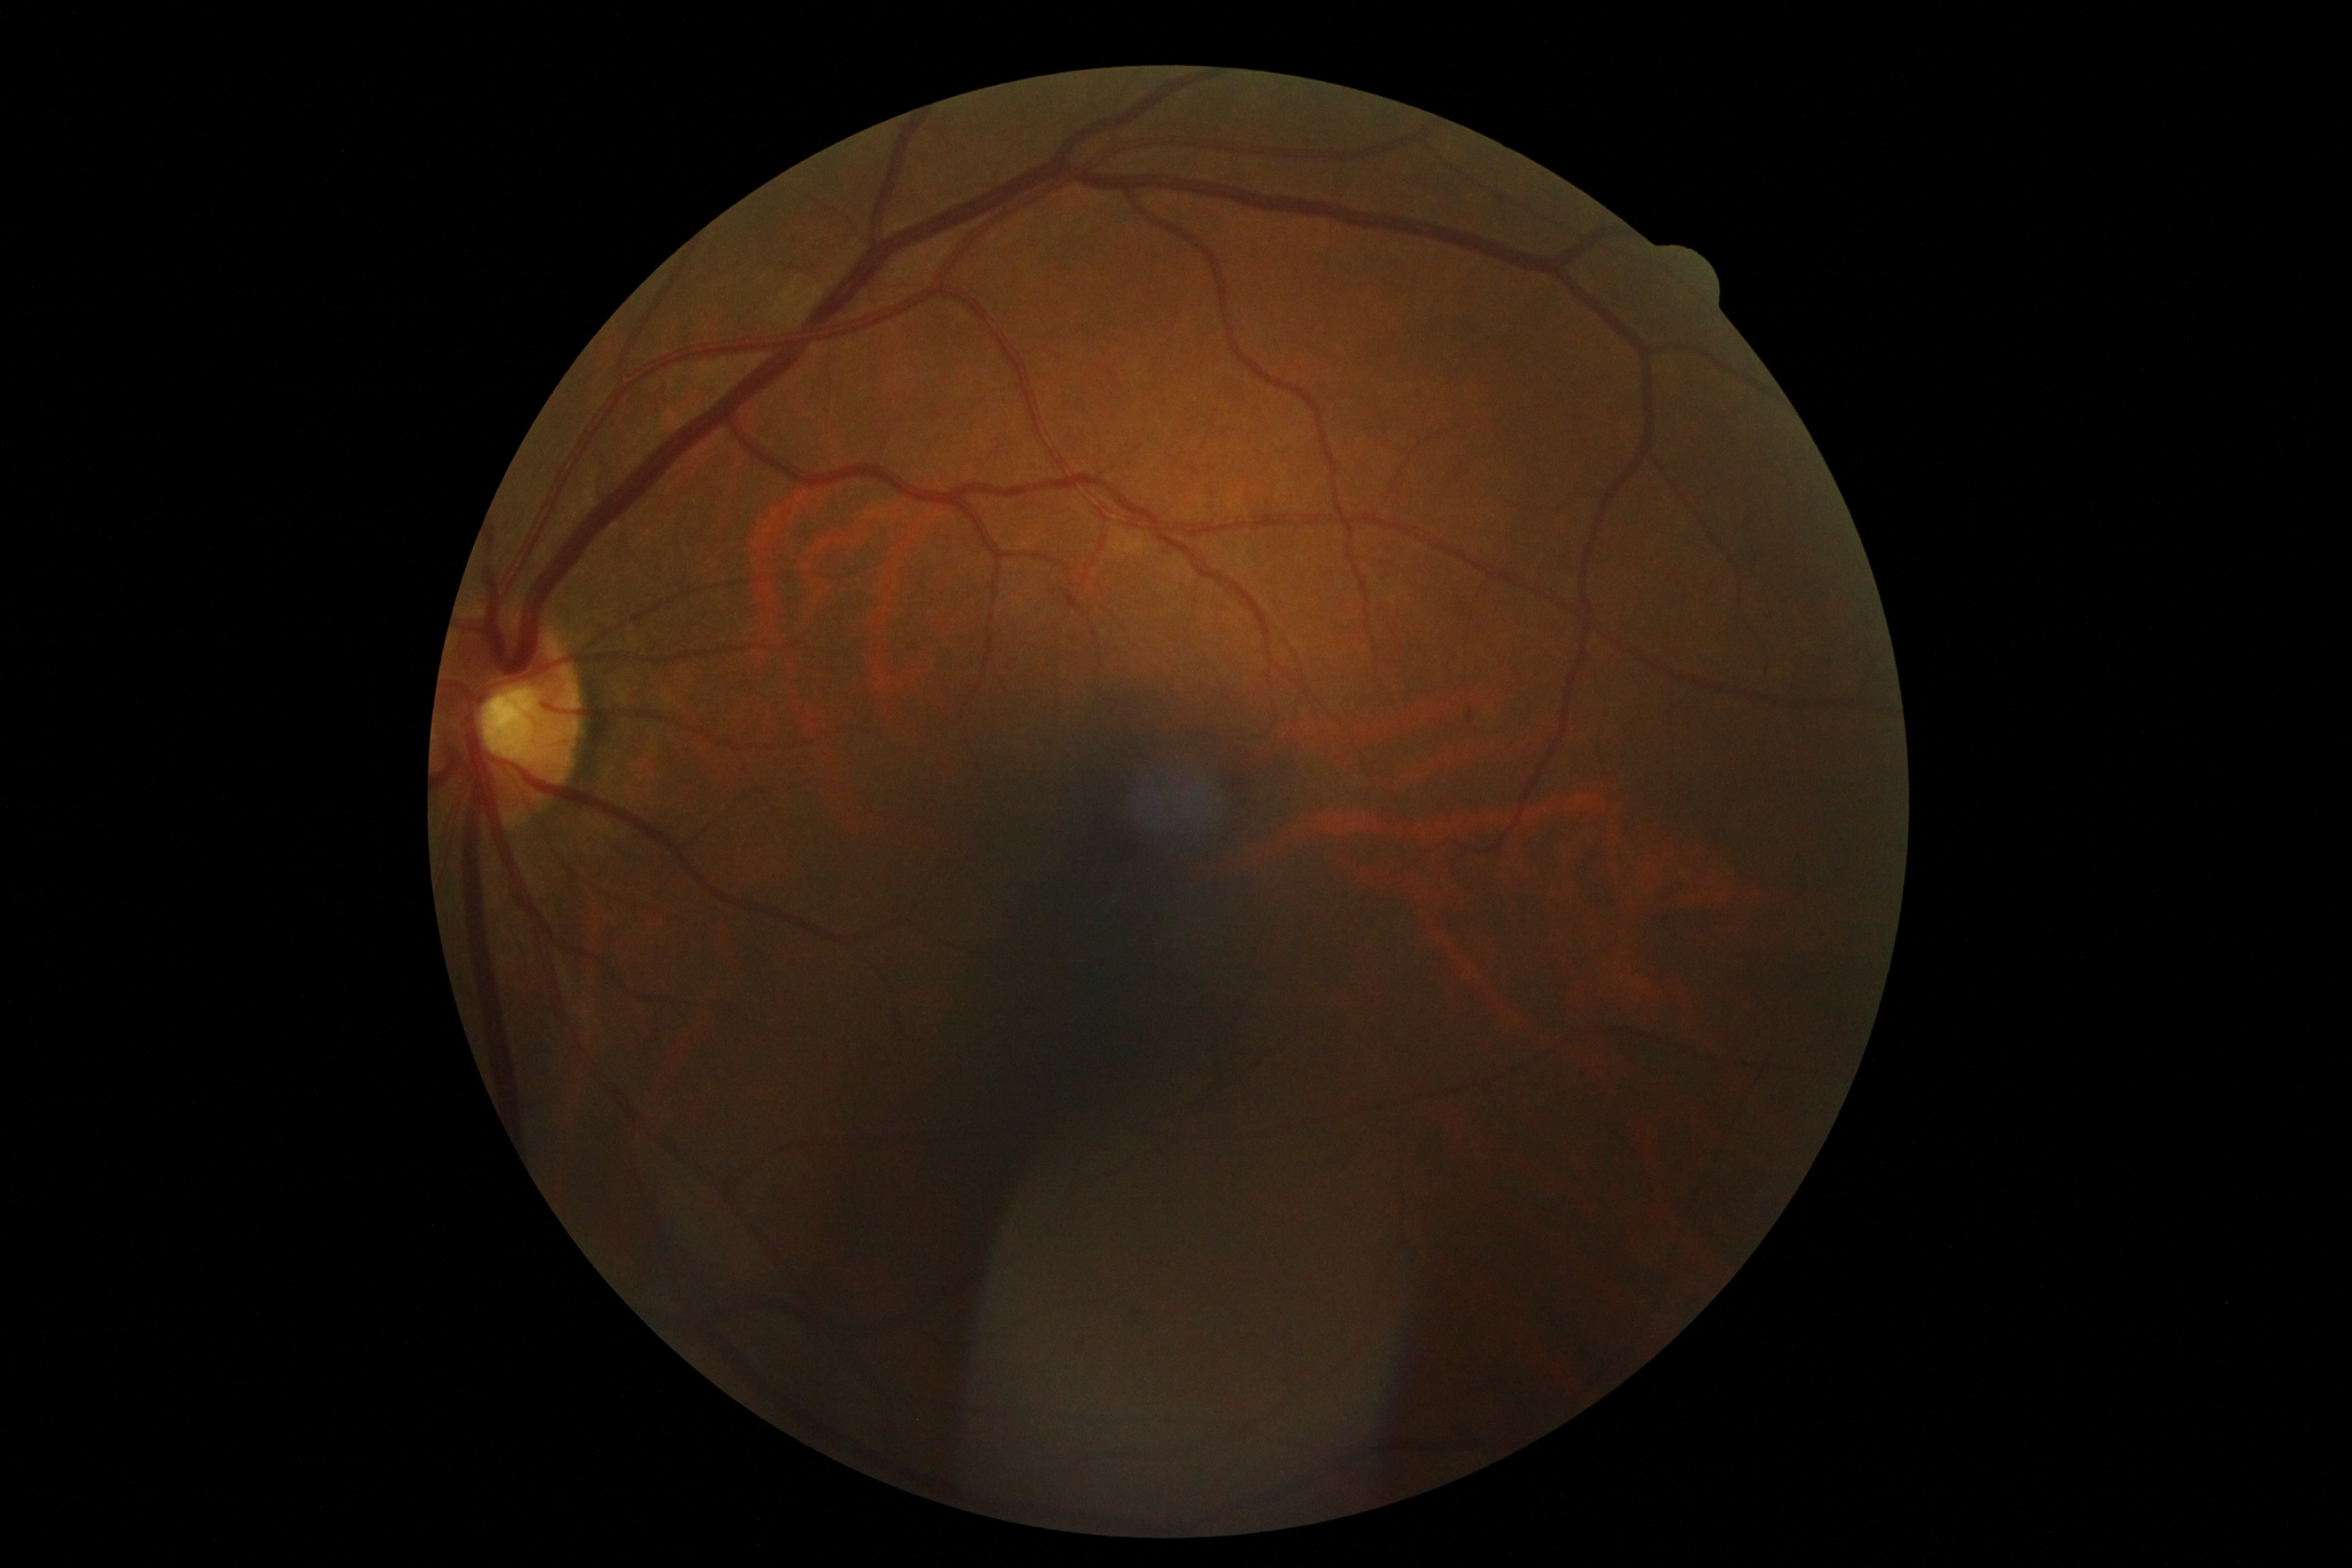 Retinopathy is grade 2 (moderate NPDR). DR class: non-proliferative diabetic retinopathy.